Graded on the modified Davis scale:
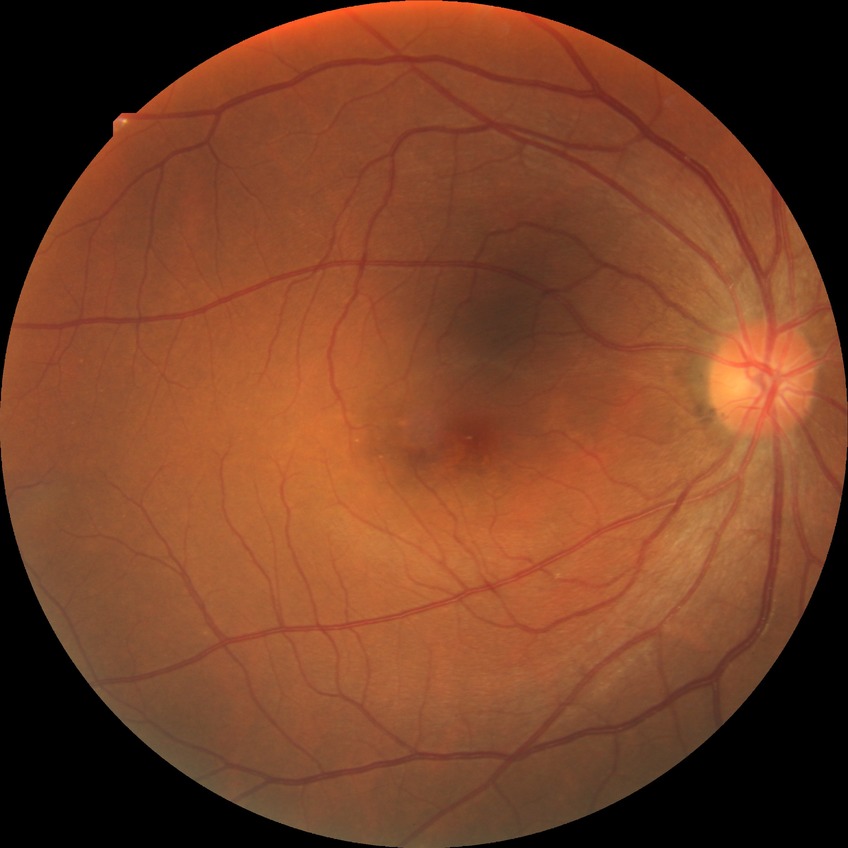 Diabetic retinopathy (DR): NDR (no diabetic retinopathy).